45° field of view · color fundus image · 1380 by 1382 pixels — 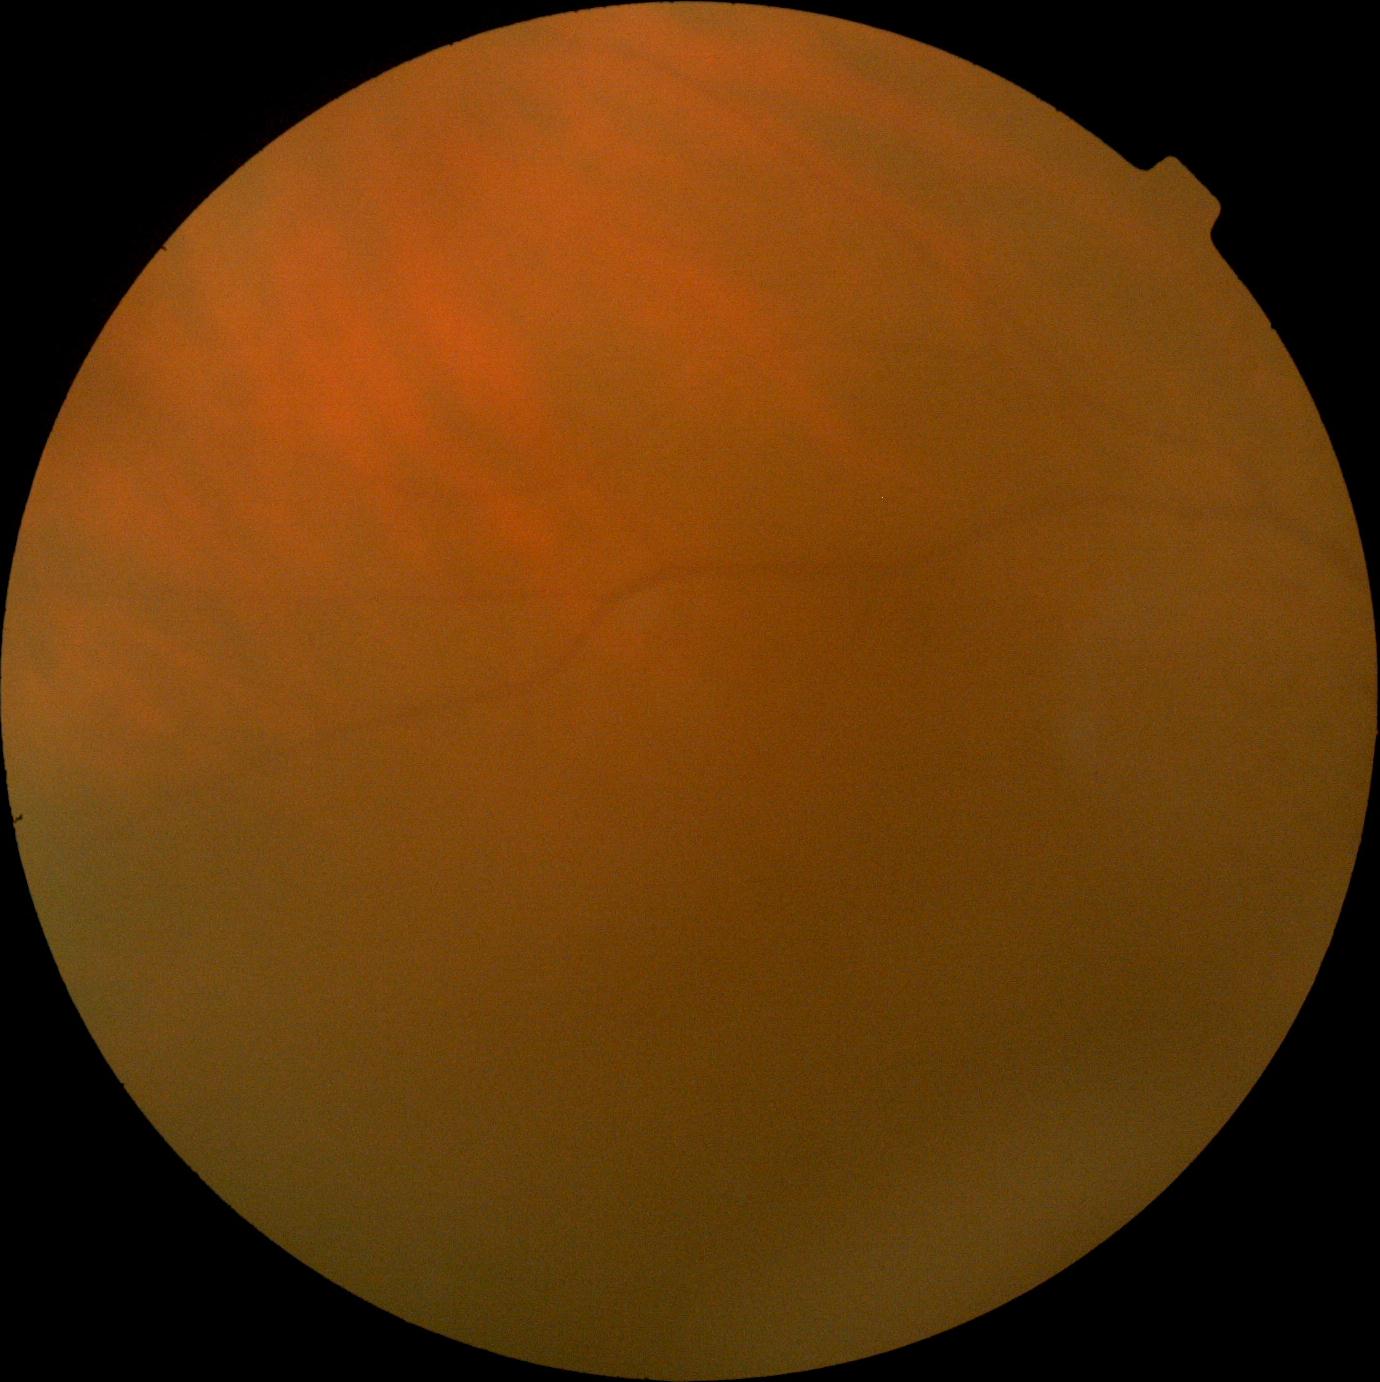 DR stage: ungradable due to poor image quality | image quality: insufficient for DR assessment.